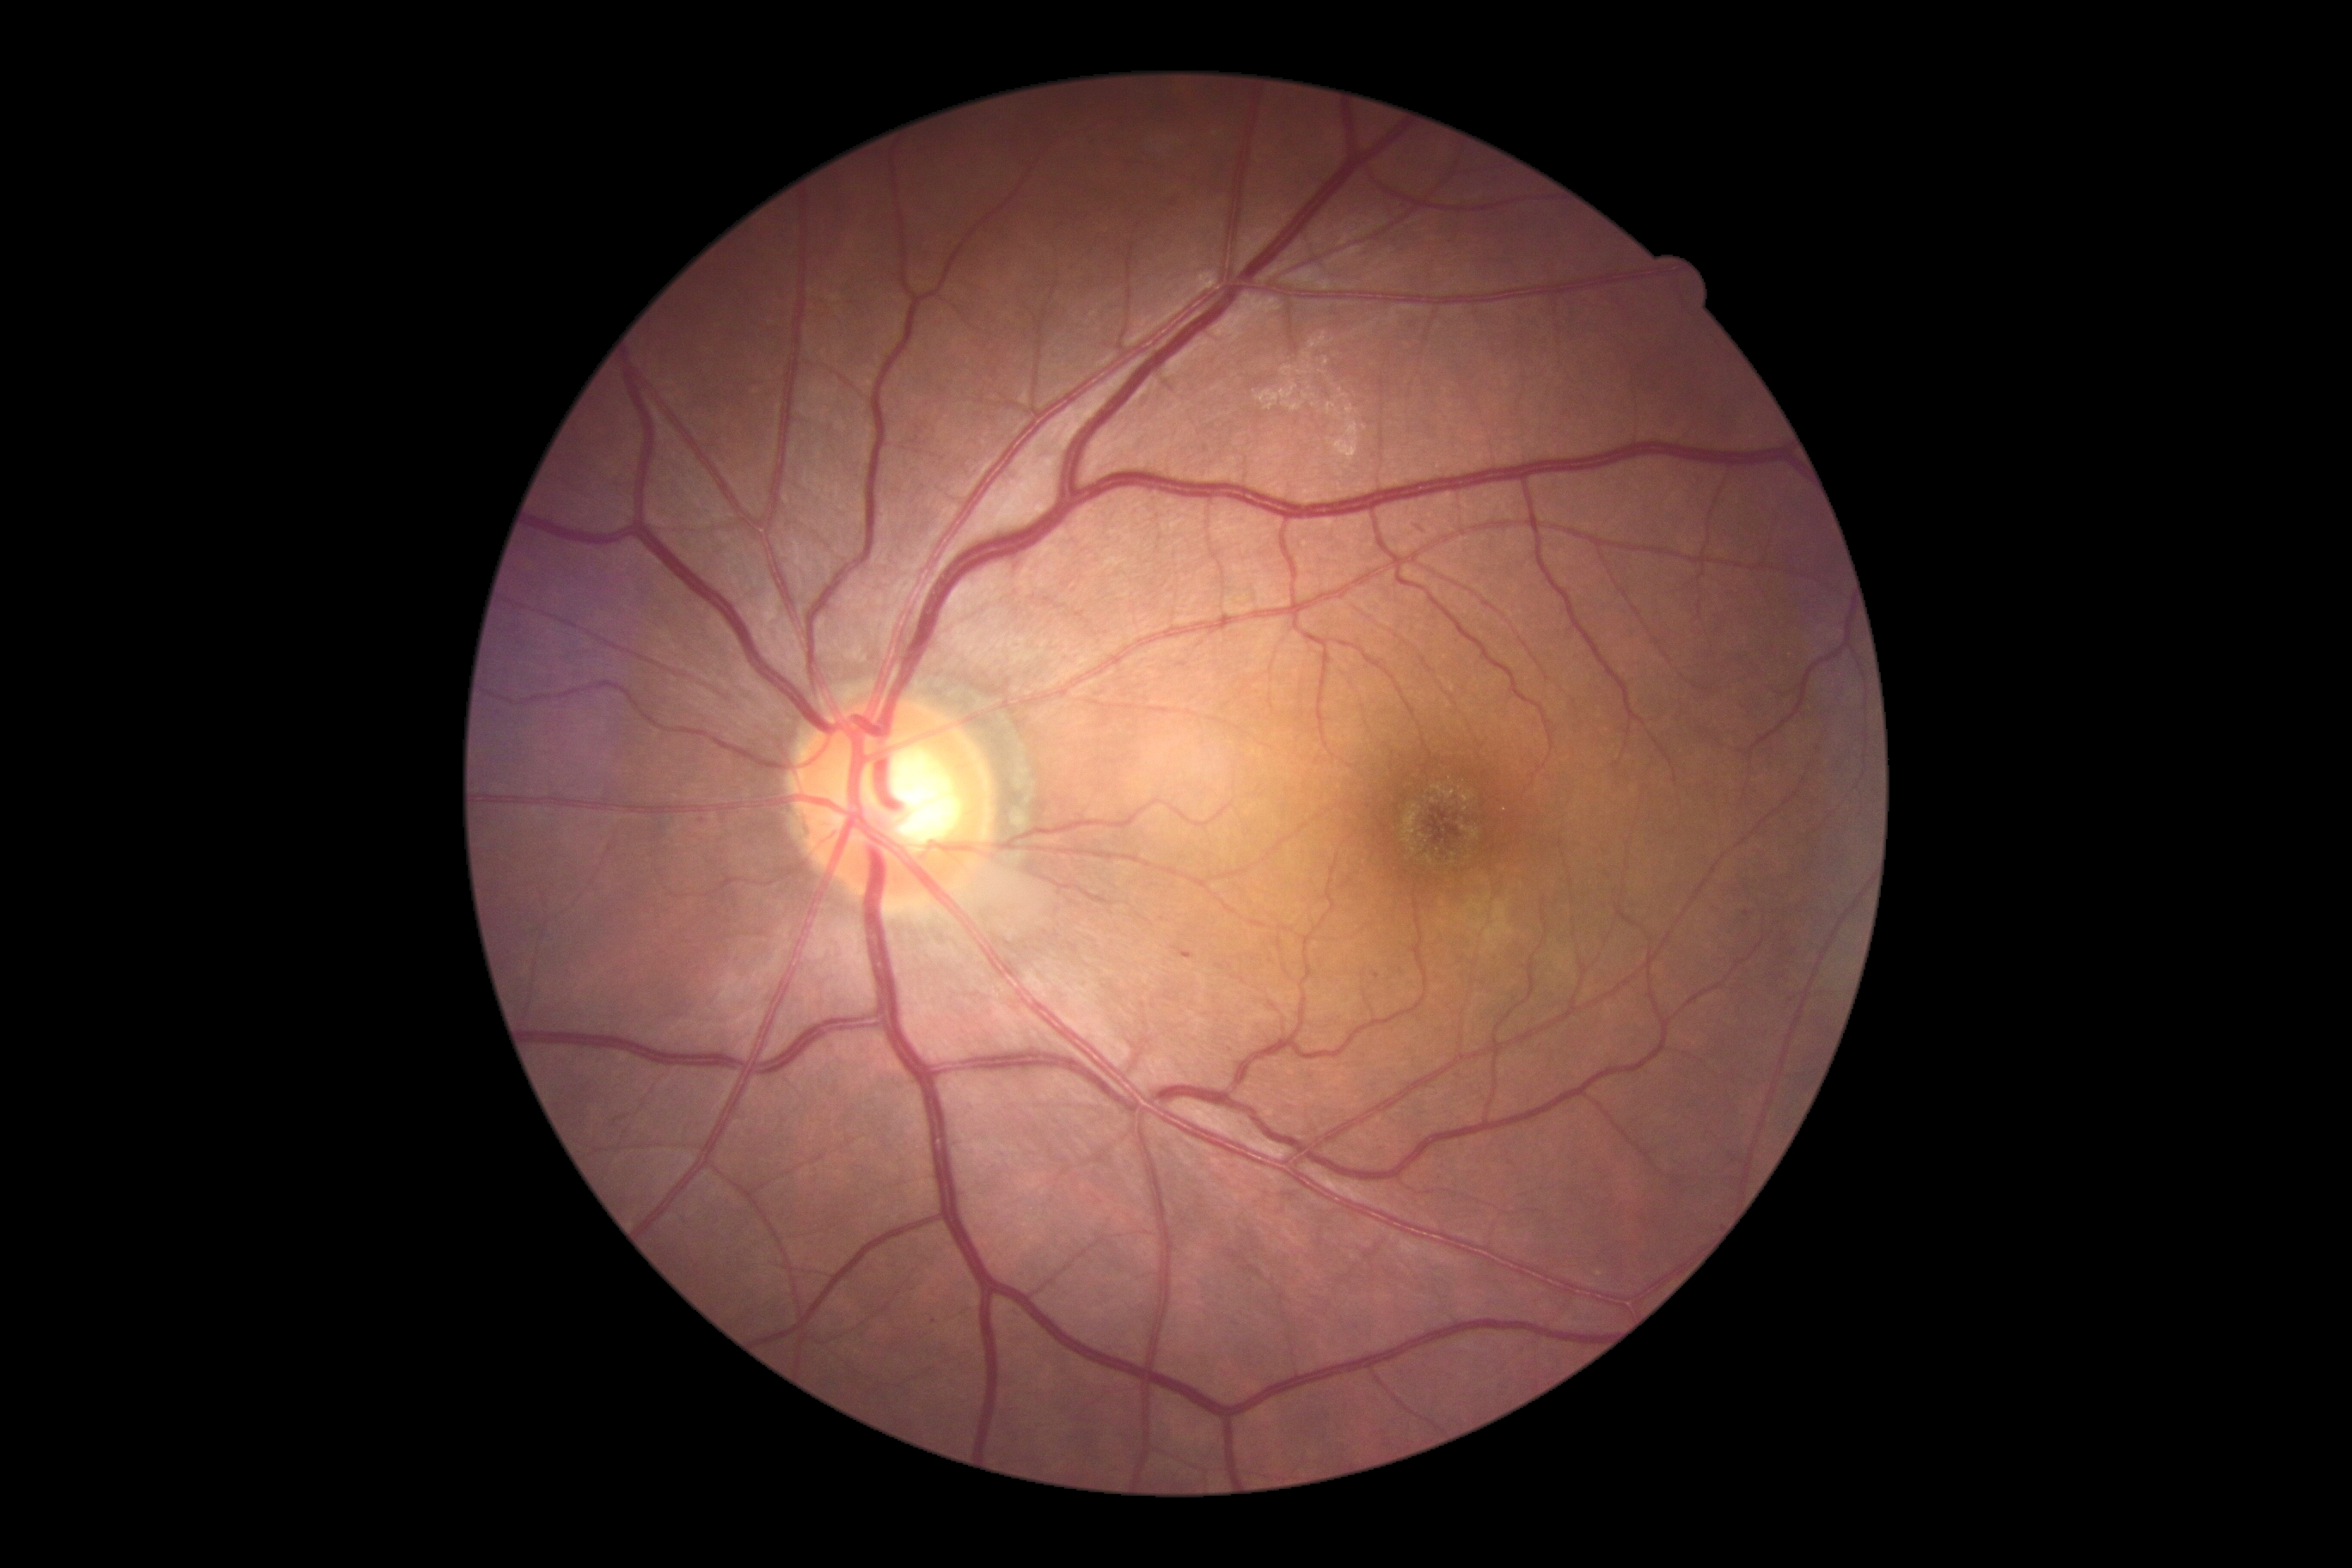

Diabetic retinopathy (DR): 1.